640x480. Wide-field fundus photograph from neonatal ROP screening: 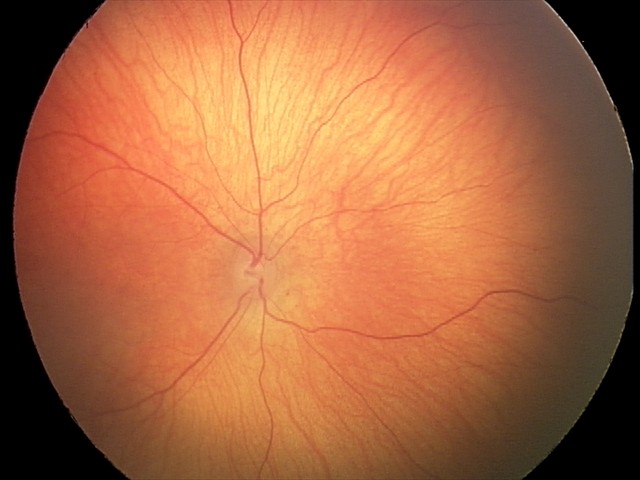 No retinal pathology identified on screening.